45° field of view; 2212 x 1659 pixels:
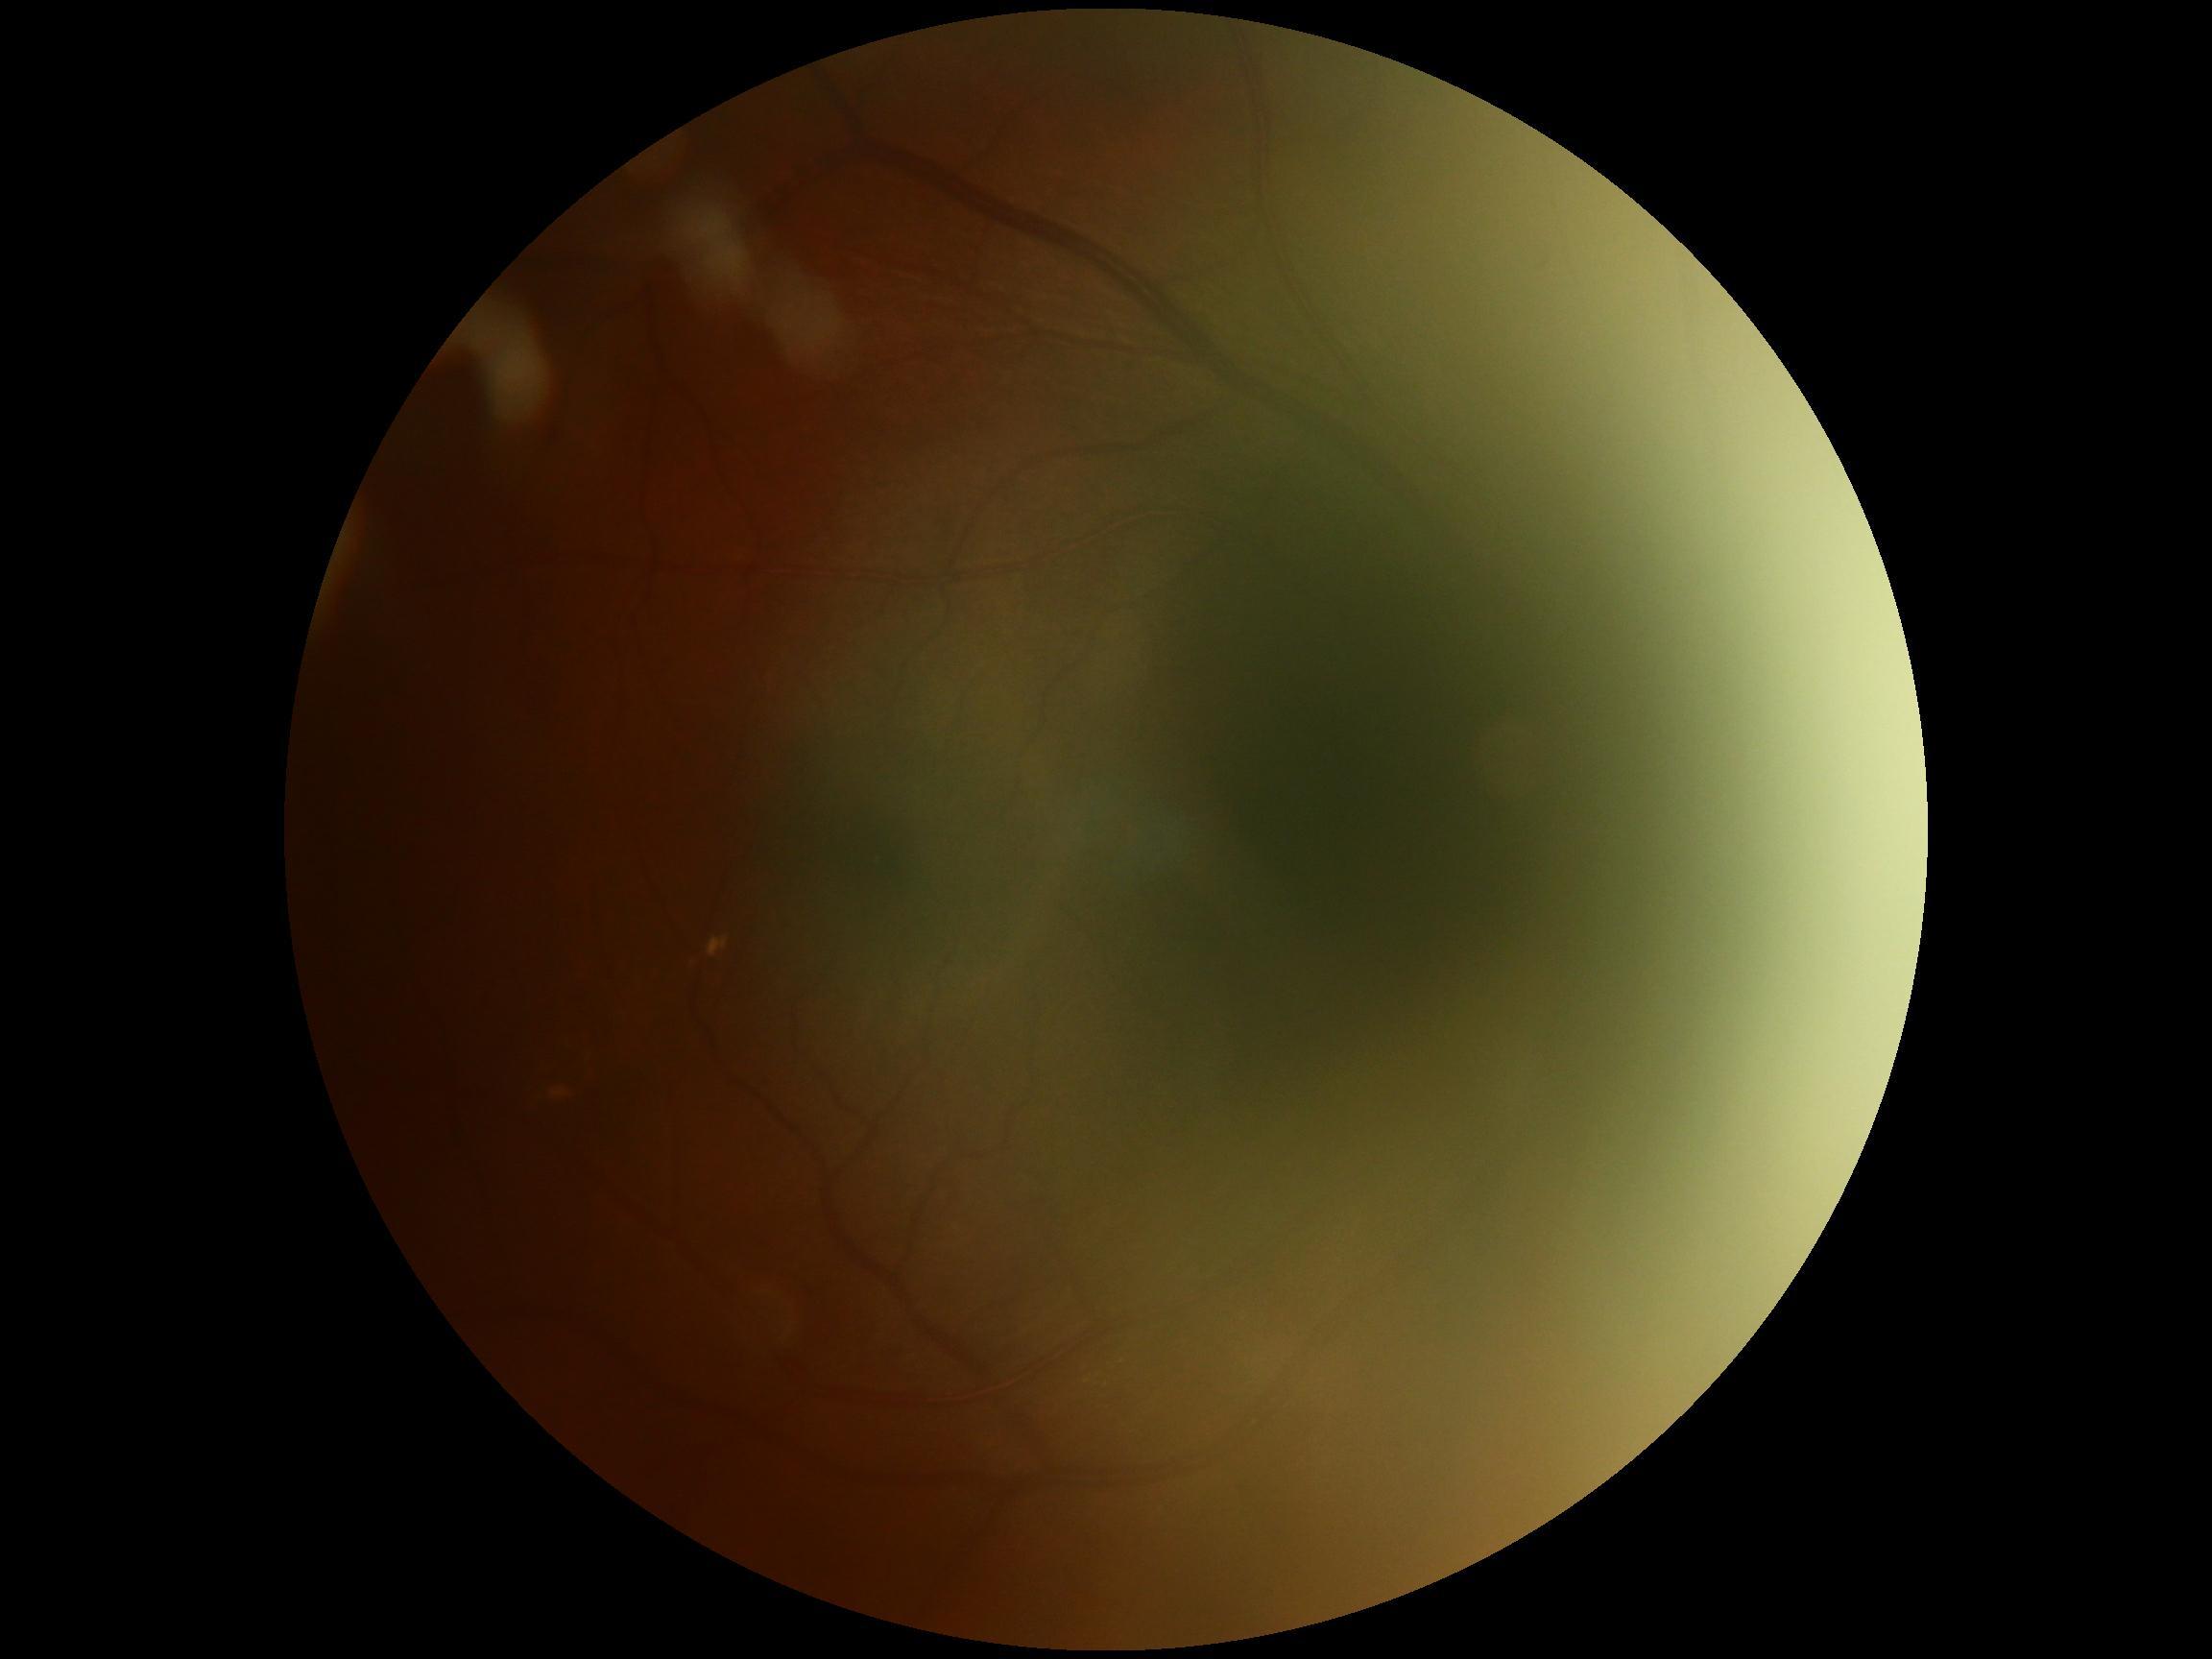

DR class: non-proliferative diabetic retinopathy | DR stage: grade 2.